Captured with the Clarity RetCam 3 (130° field of view); 640x480px; wide-field contact fundus photograph of an infant — 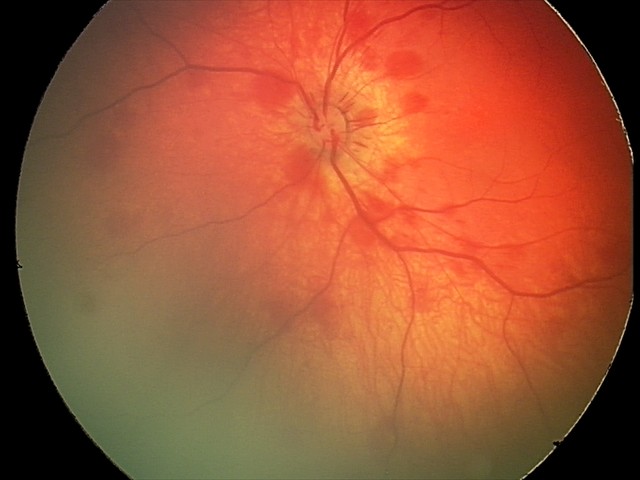 Screening examination consistent with retinal hemorrhages.